Image size 2212x1659 · 45° FOV:
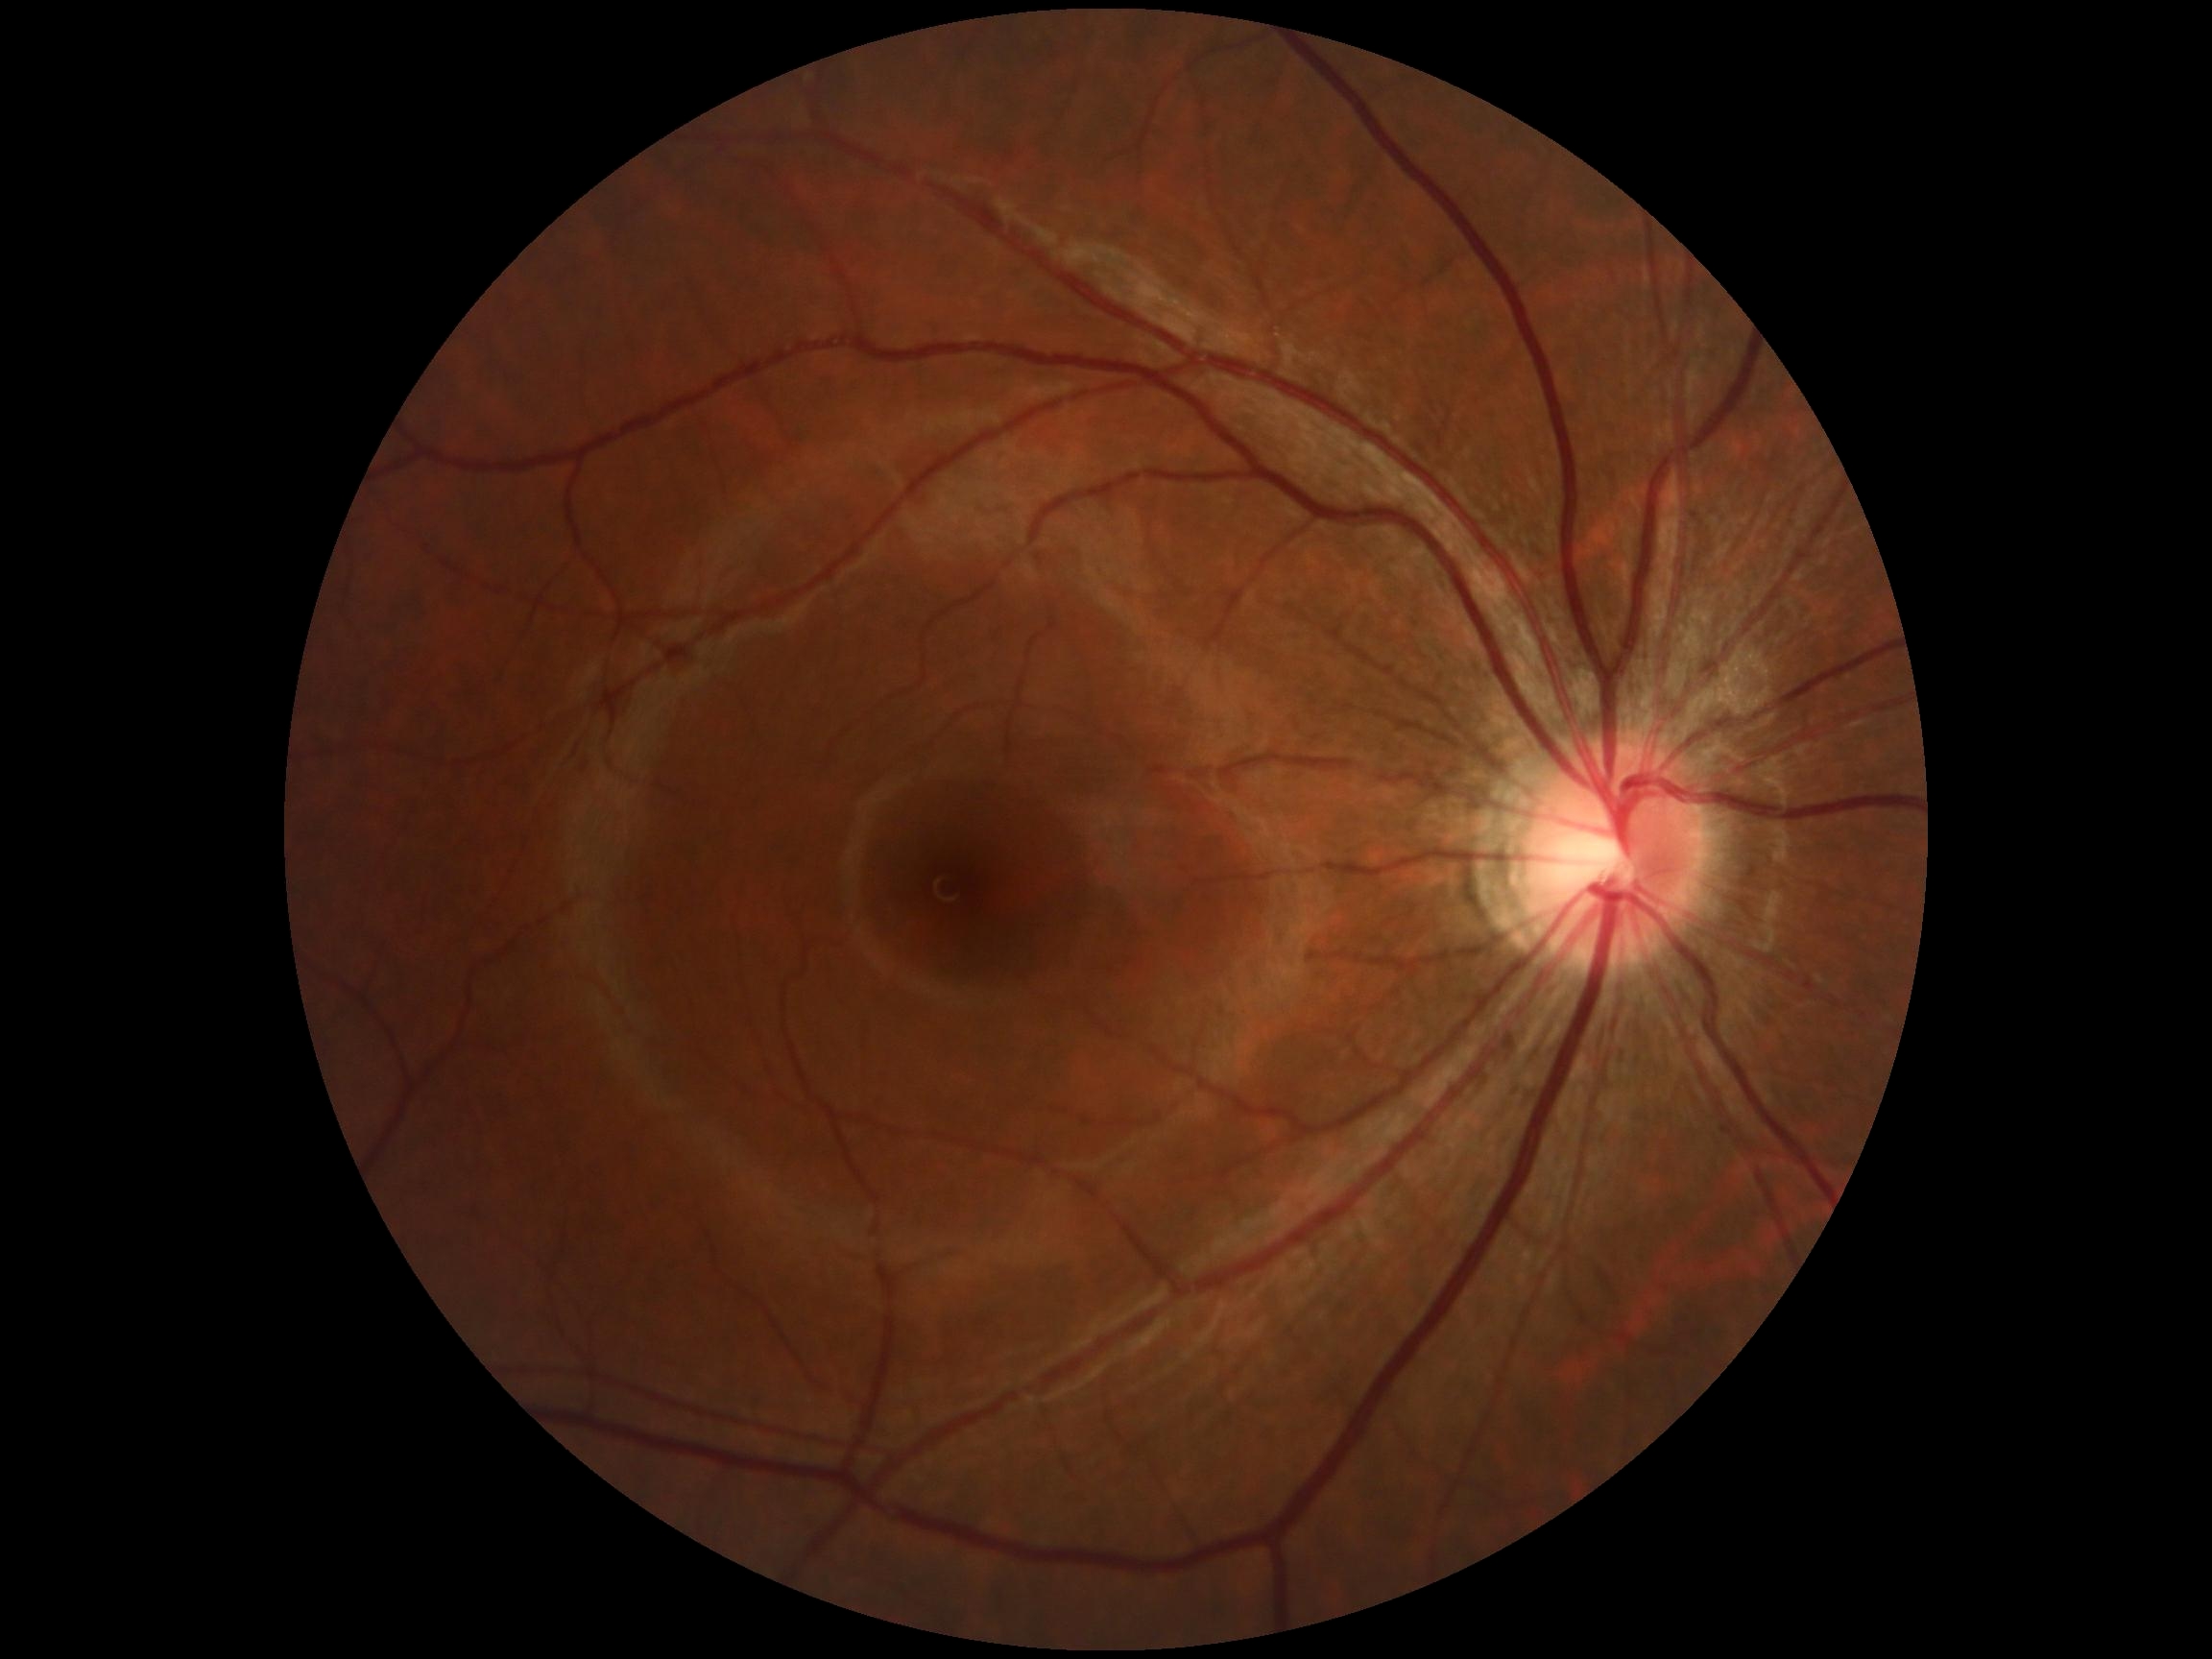 Findings:
* DR: grade 0 (no apparent retinopathy)